Color fundus image; 2352x1568:
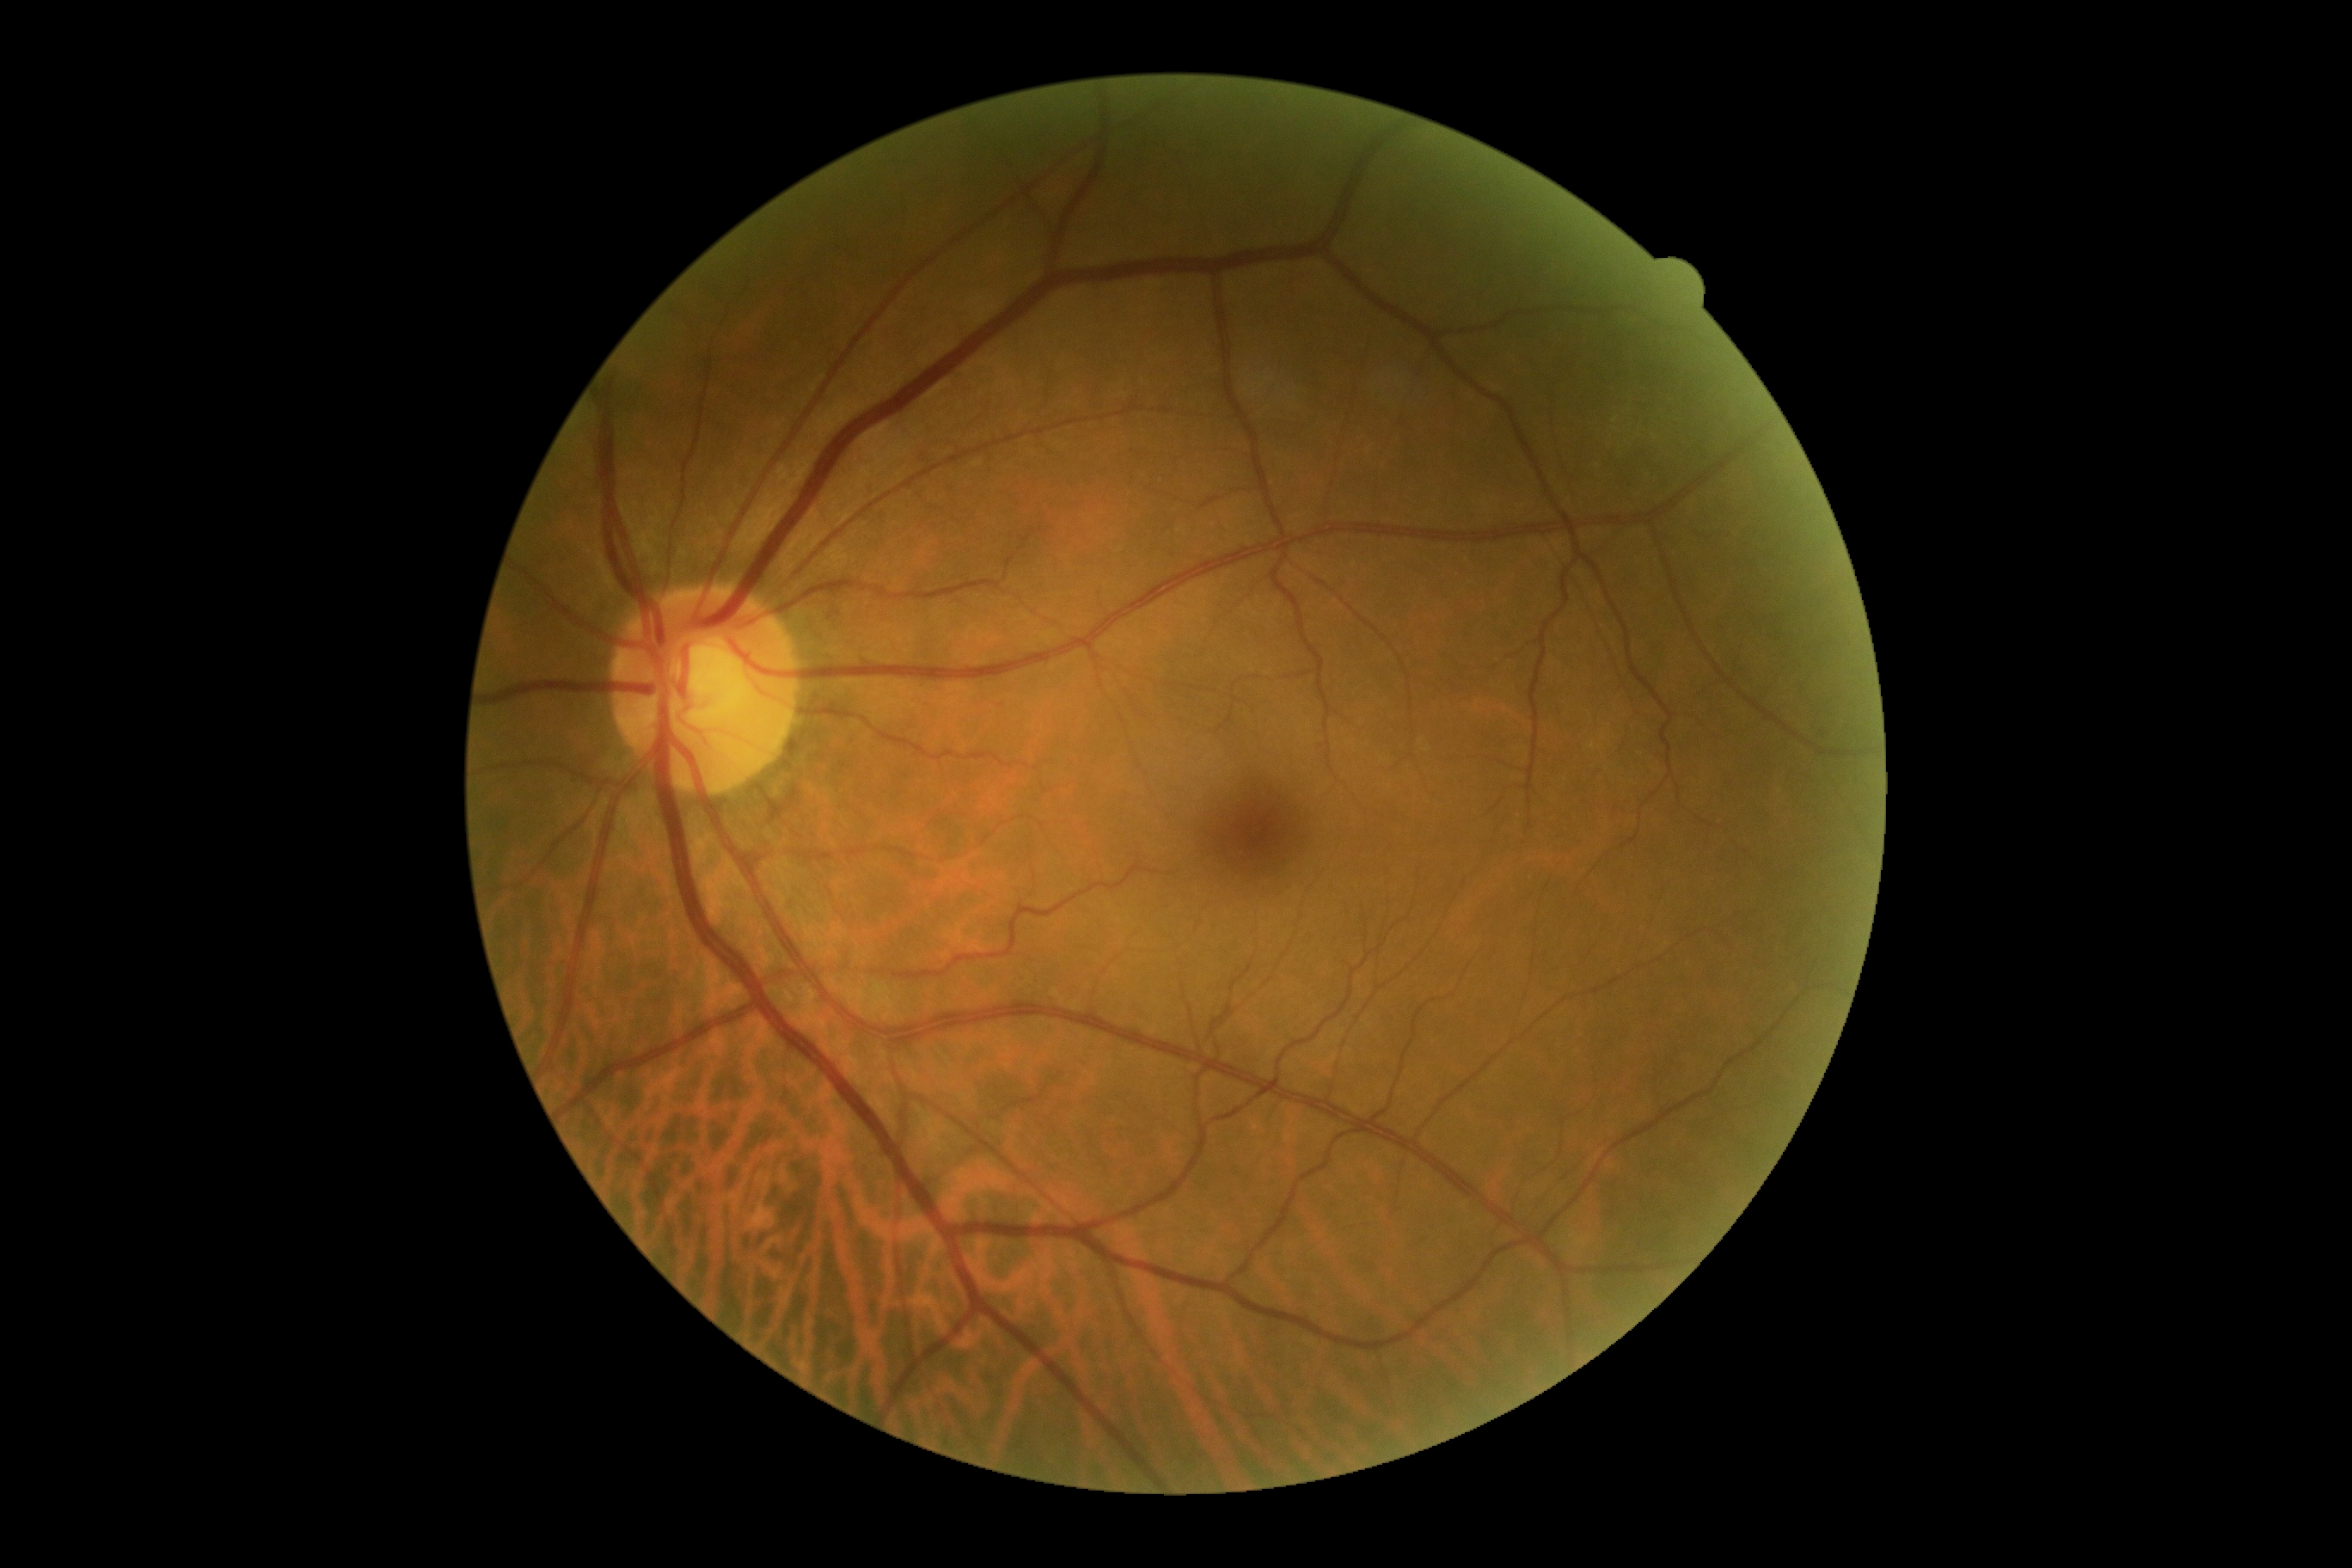 DR grade=no apparent retinopathy (0).